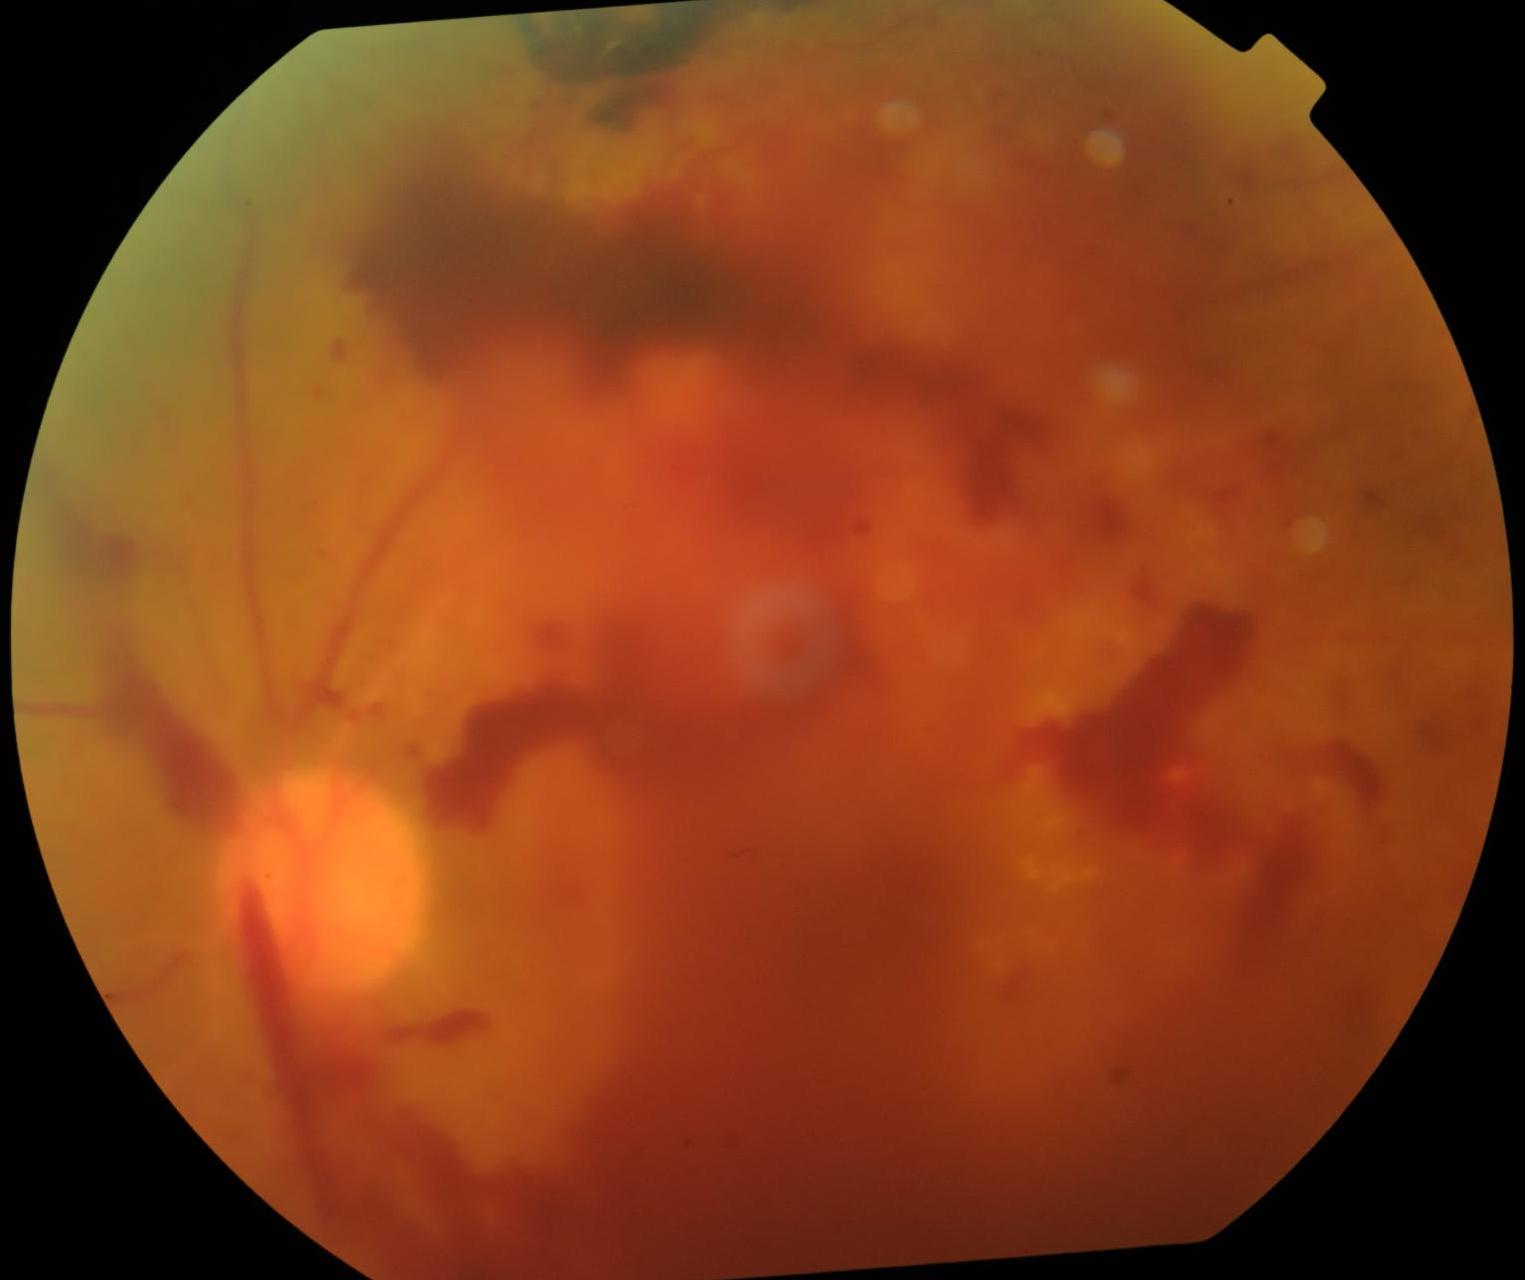 Findings:
* DR grade — 4 — neovascularization and/or vitreous/pre-retinal hemorrhage